Color fundus photograph:
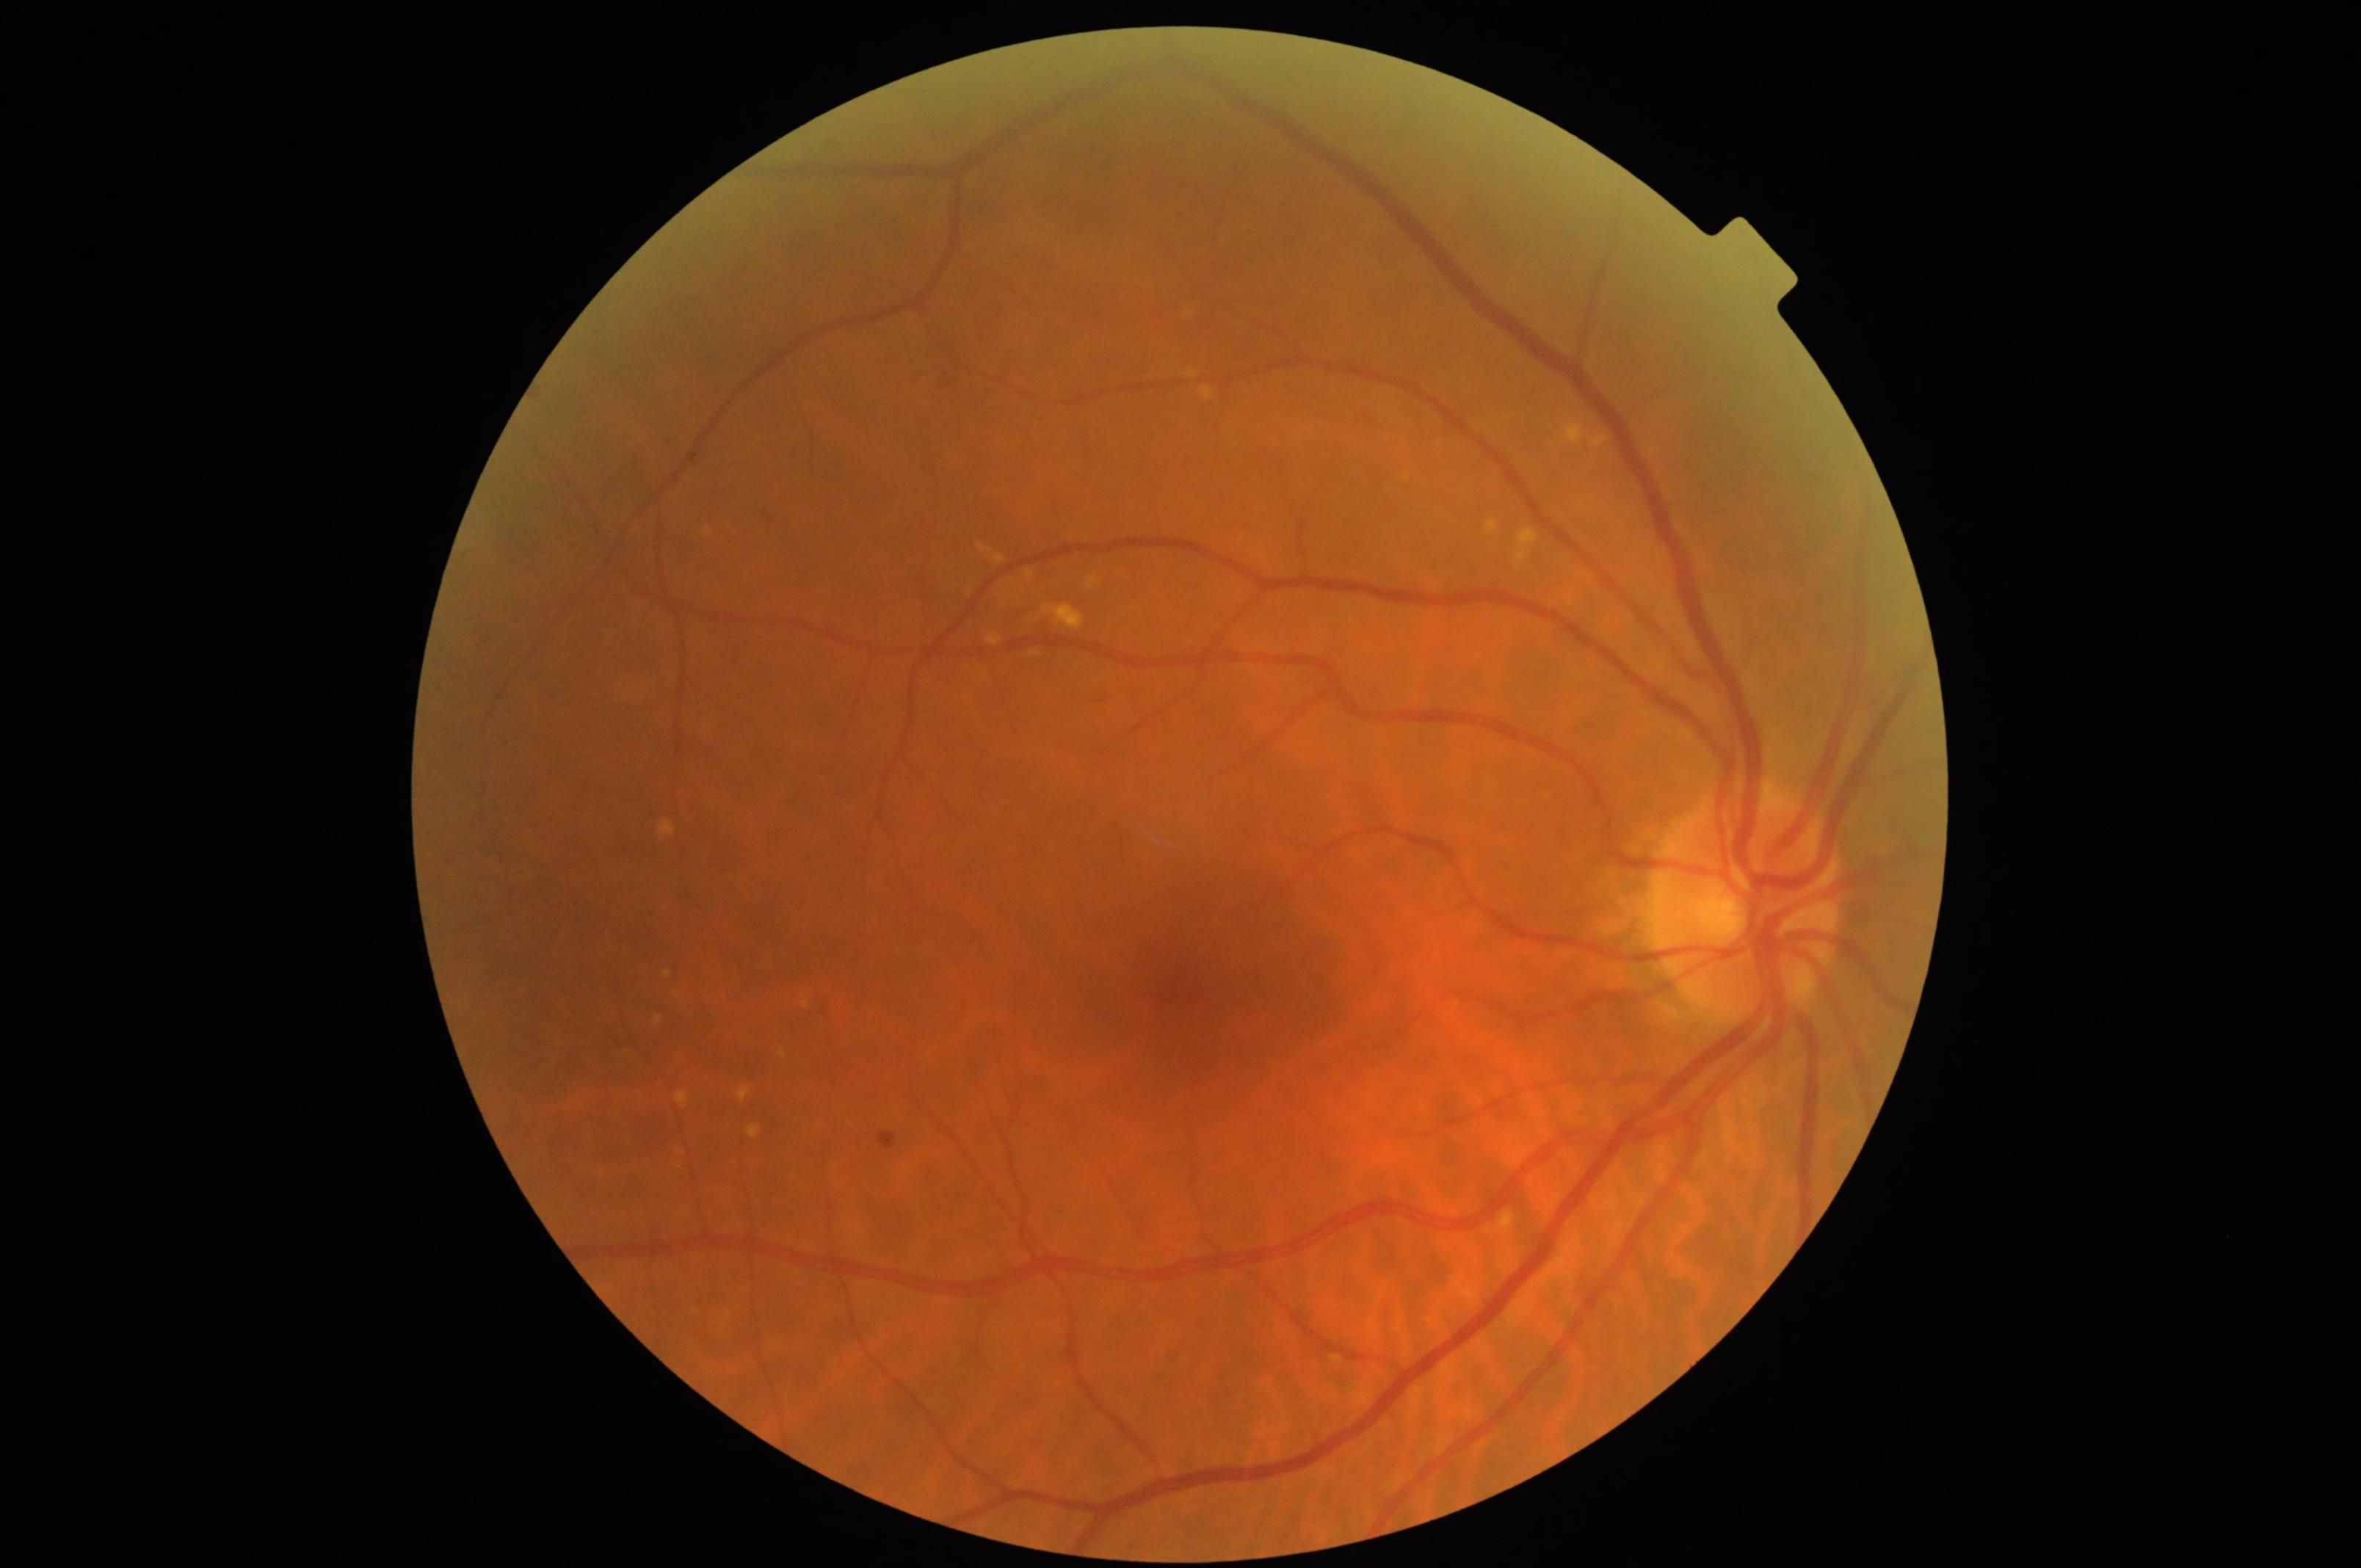 Vessels and details are readily distinguishable. Acceptable image quality. No over- or under-exposure. The image is clear.